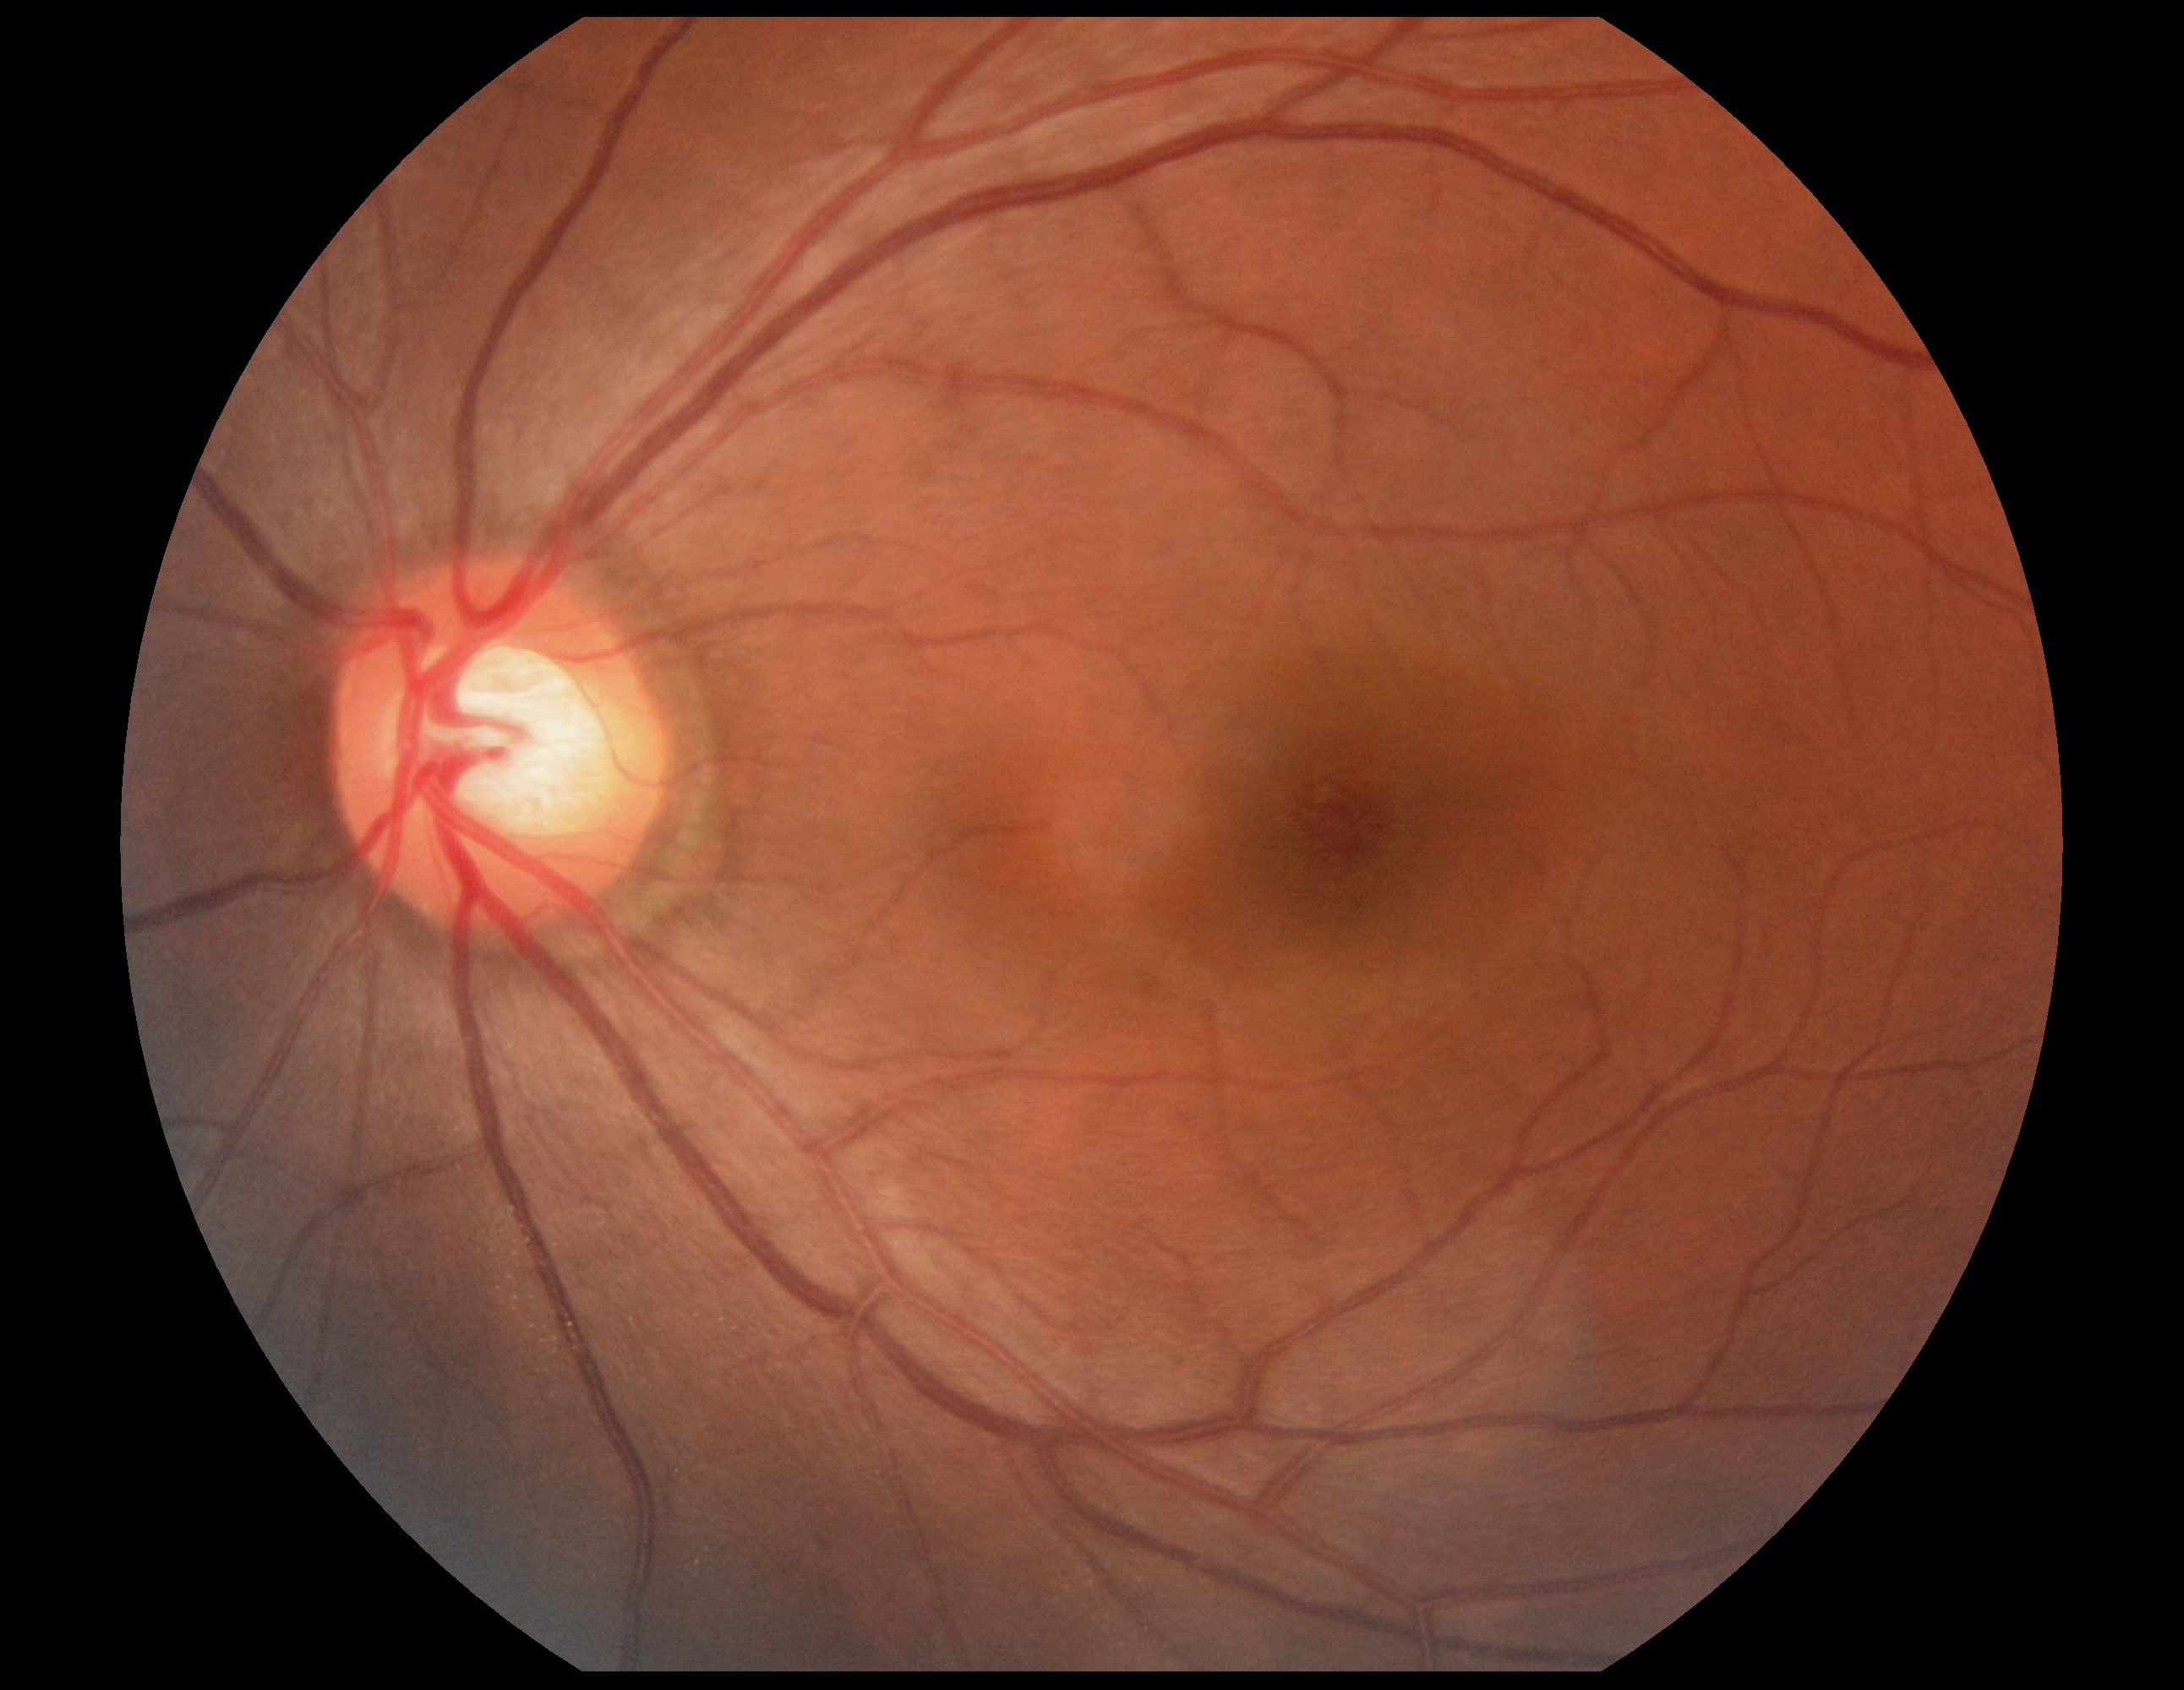

DR stage is grade 0.